Wide-field contact fundus photograph of an infant. Image size 1440x1080: 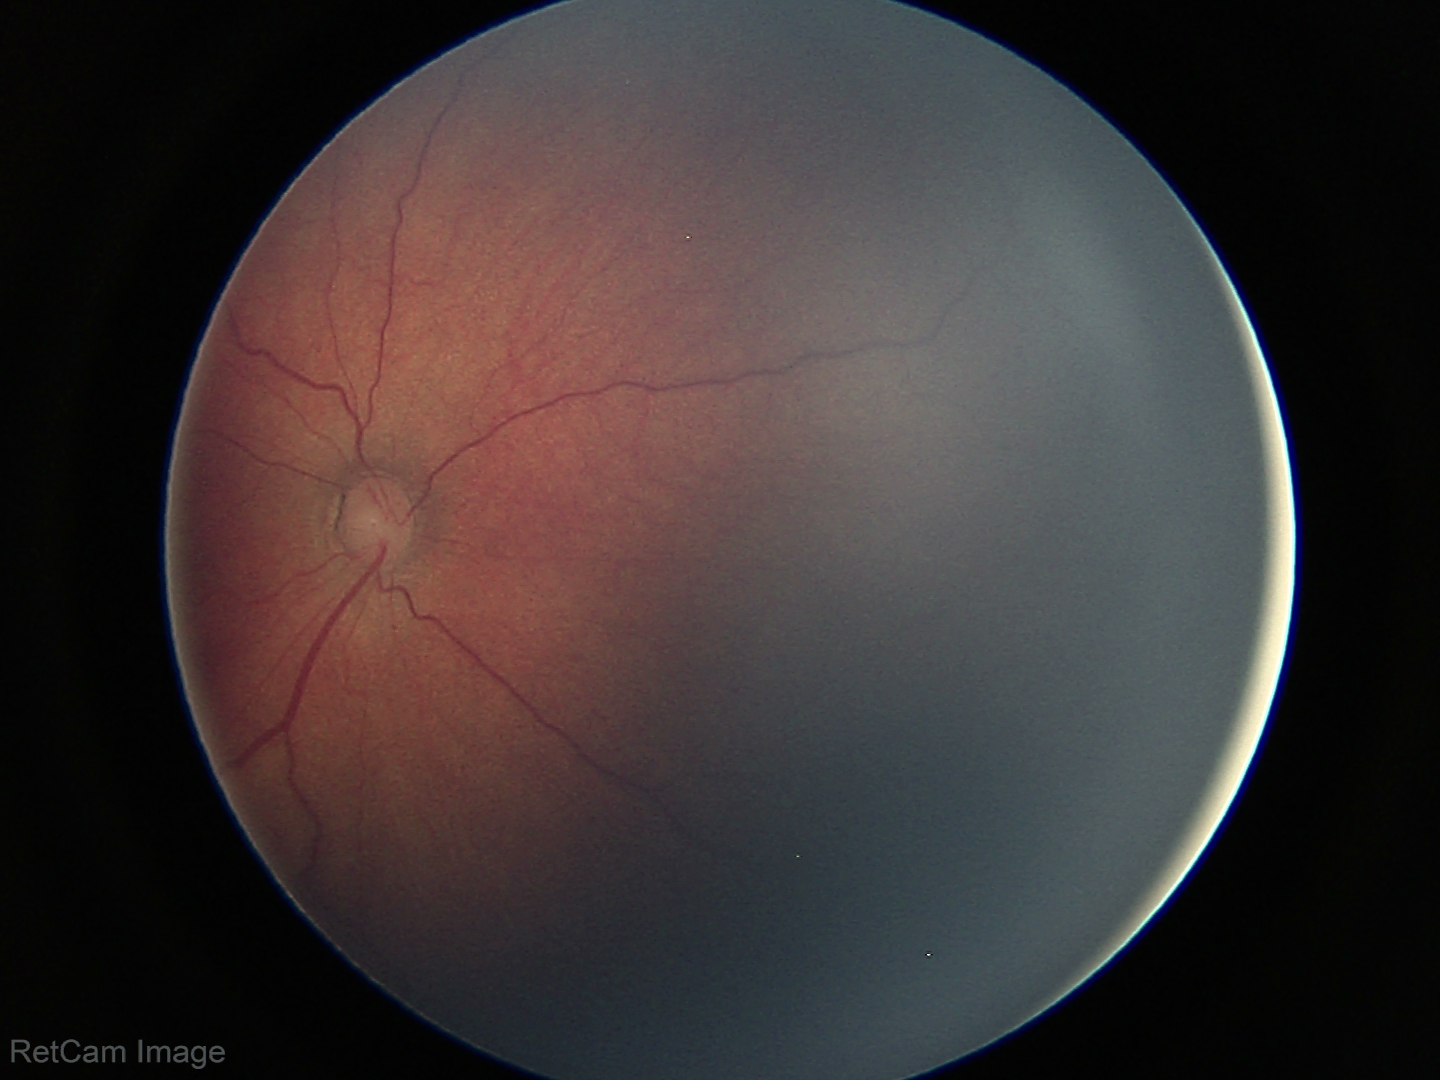
Screening series with retinopathy of prematurity stage 3 — ridge with extraretinal fibrovascular proliferation.
No plus disease.